Camera: NIDEK AFC-230. Posterior pole photograph. Nonmydriatic. 45-degree field of view. 848x848px — 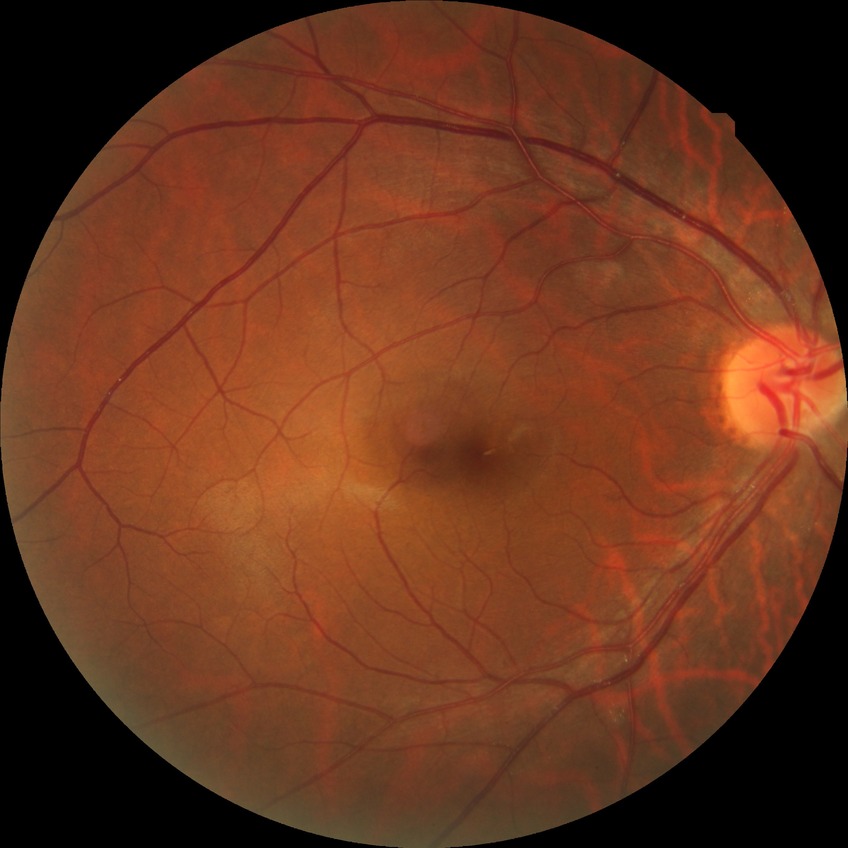
Retinopathy grade: no diabetic retinopathy.